45° FOV: 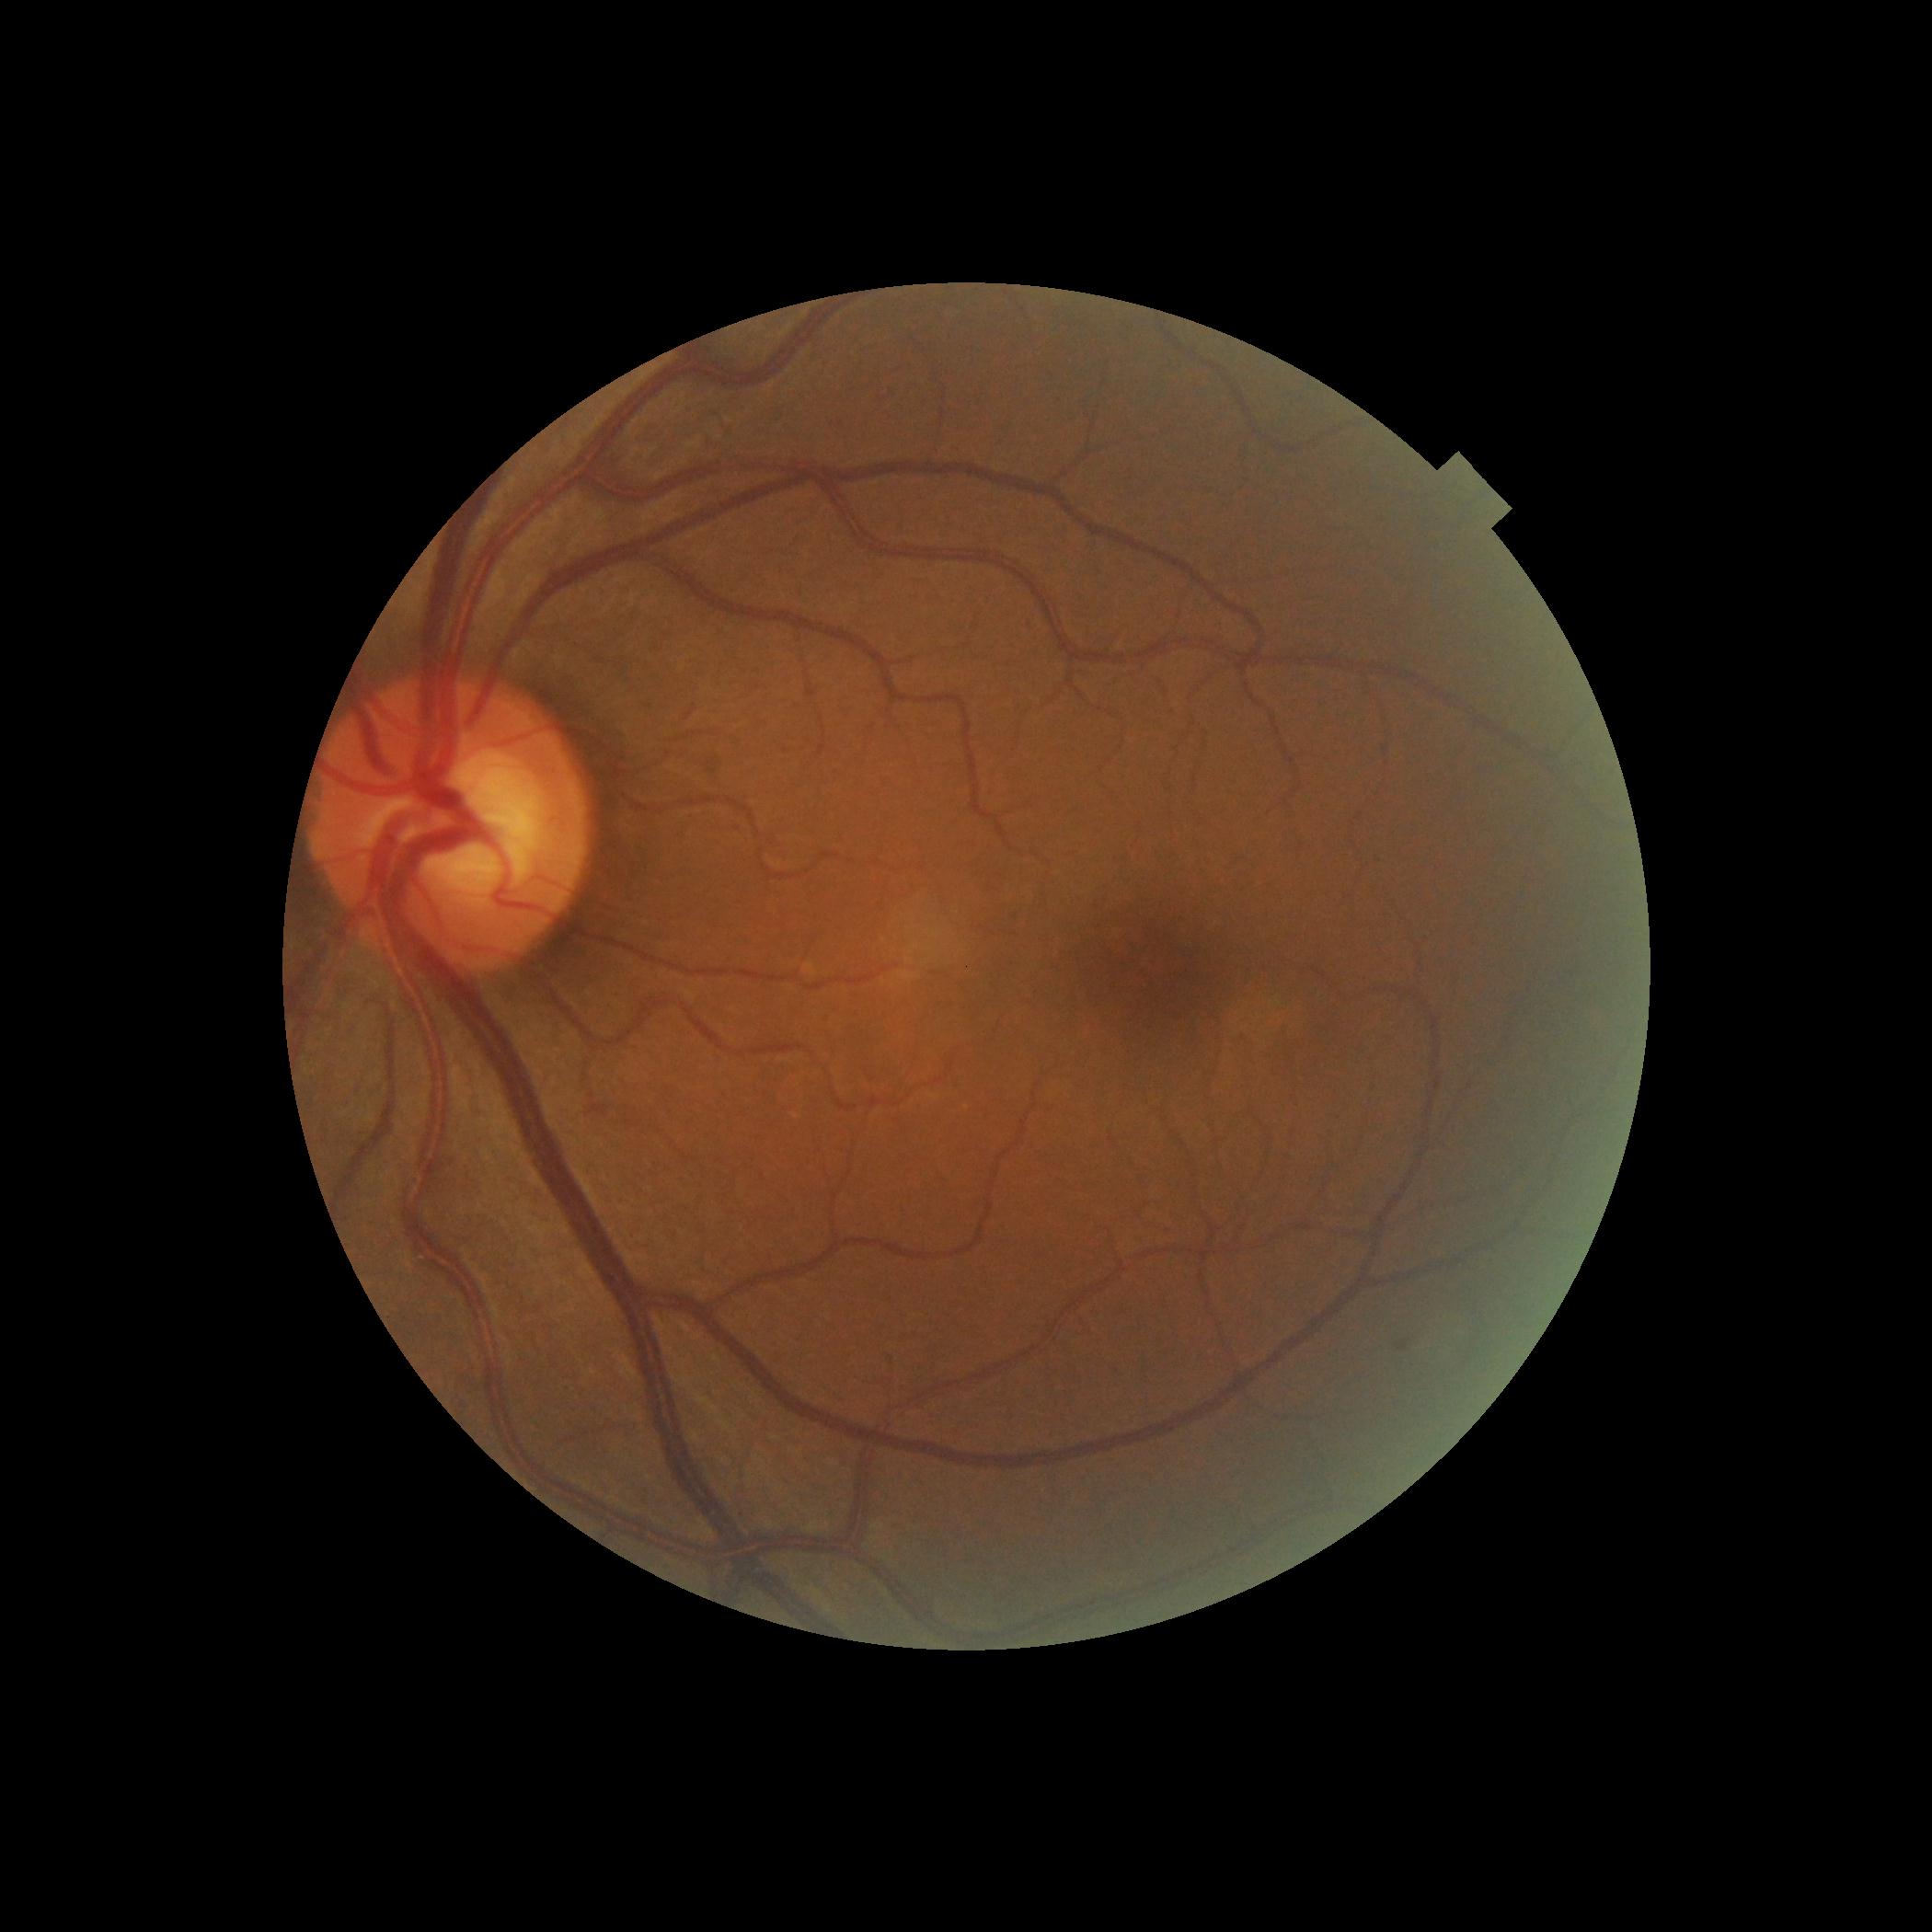 No apparent diabetic retinopathy. DR stage is grade 0.